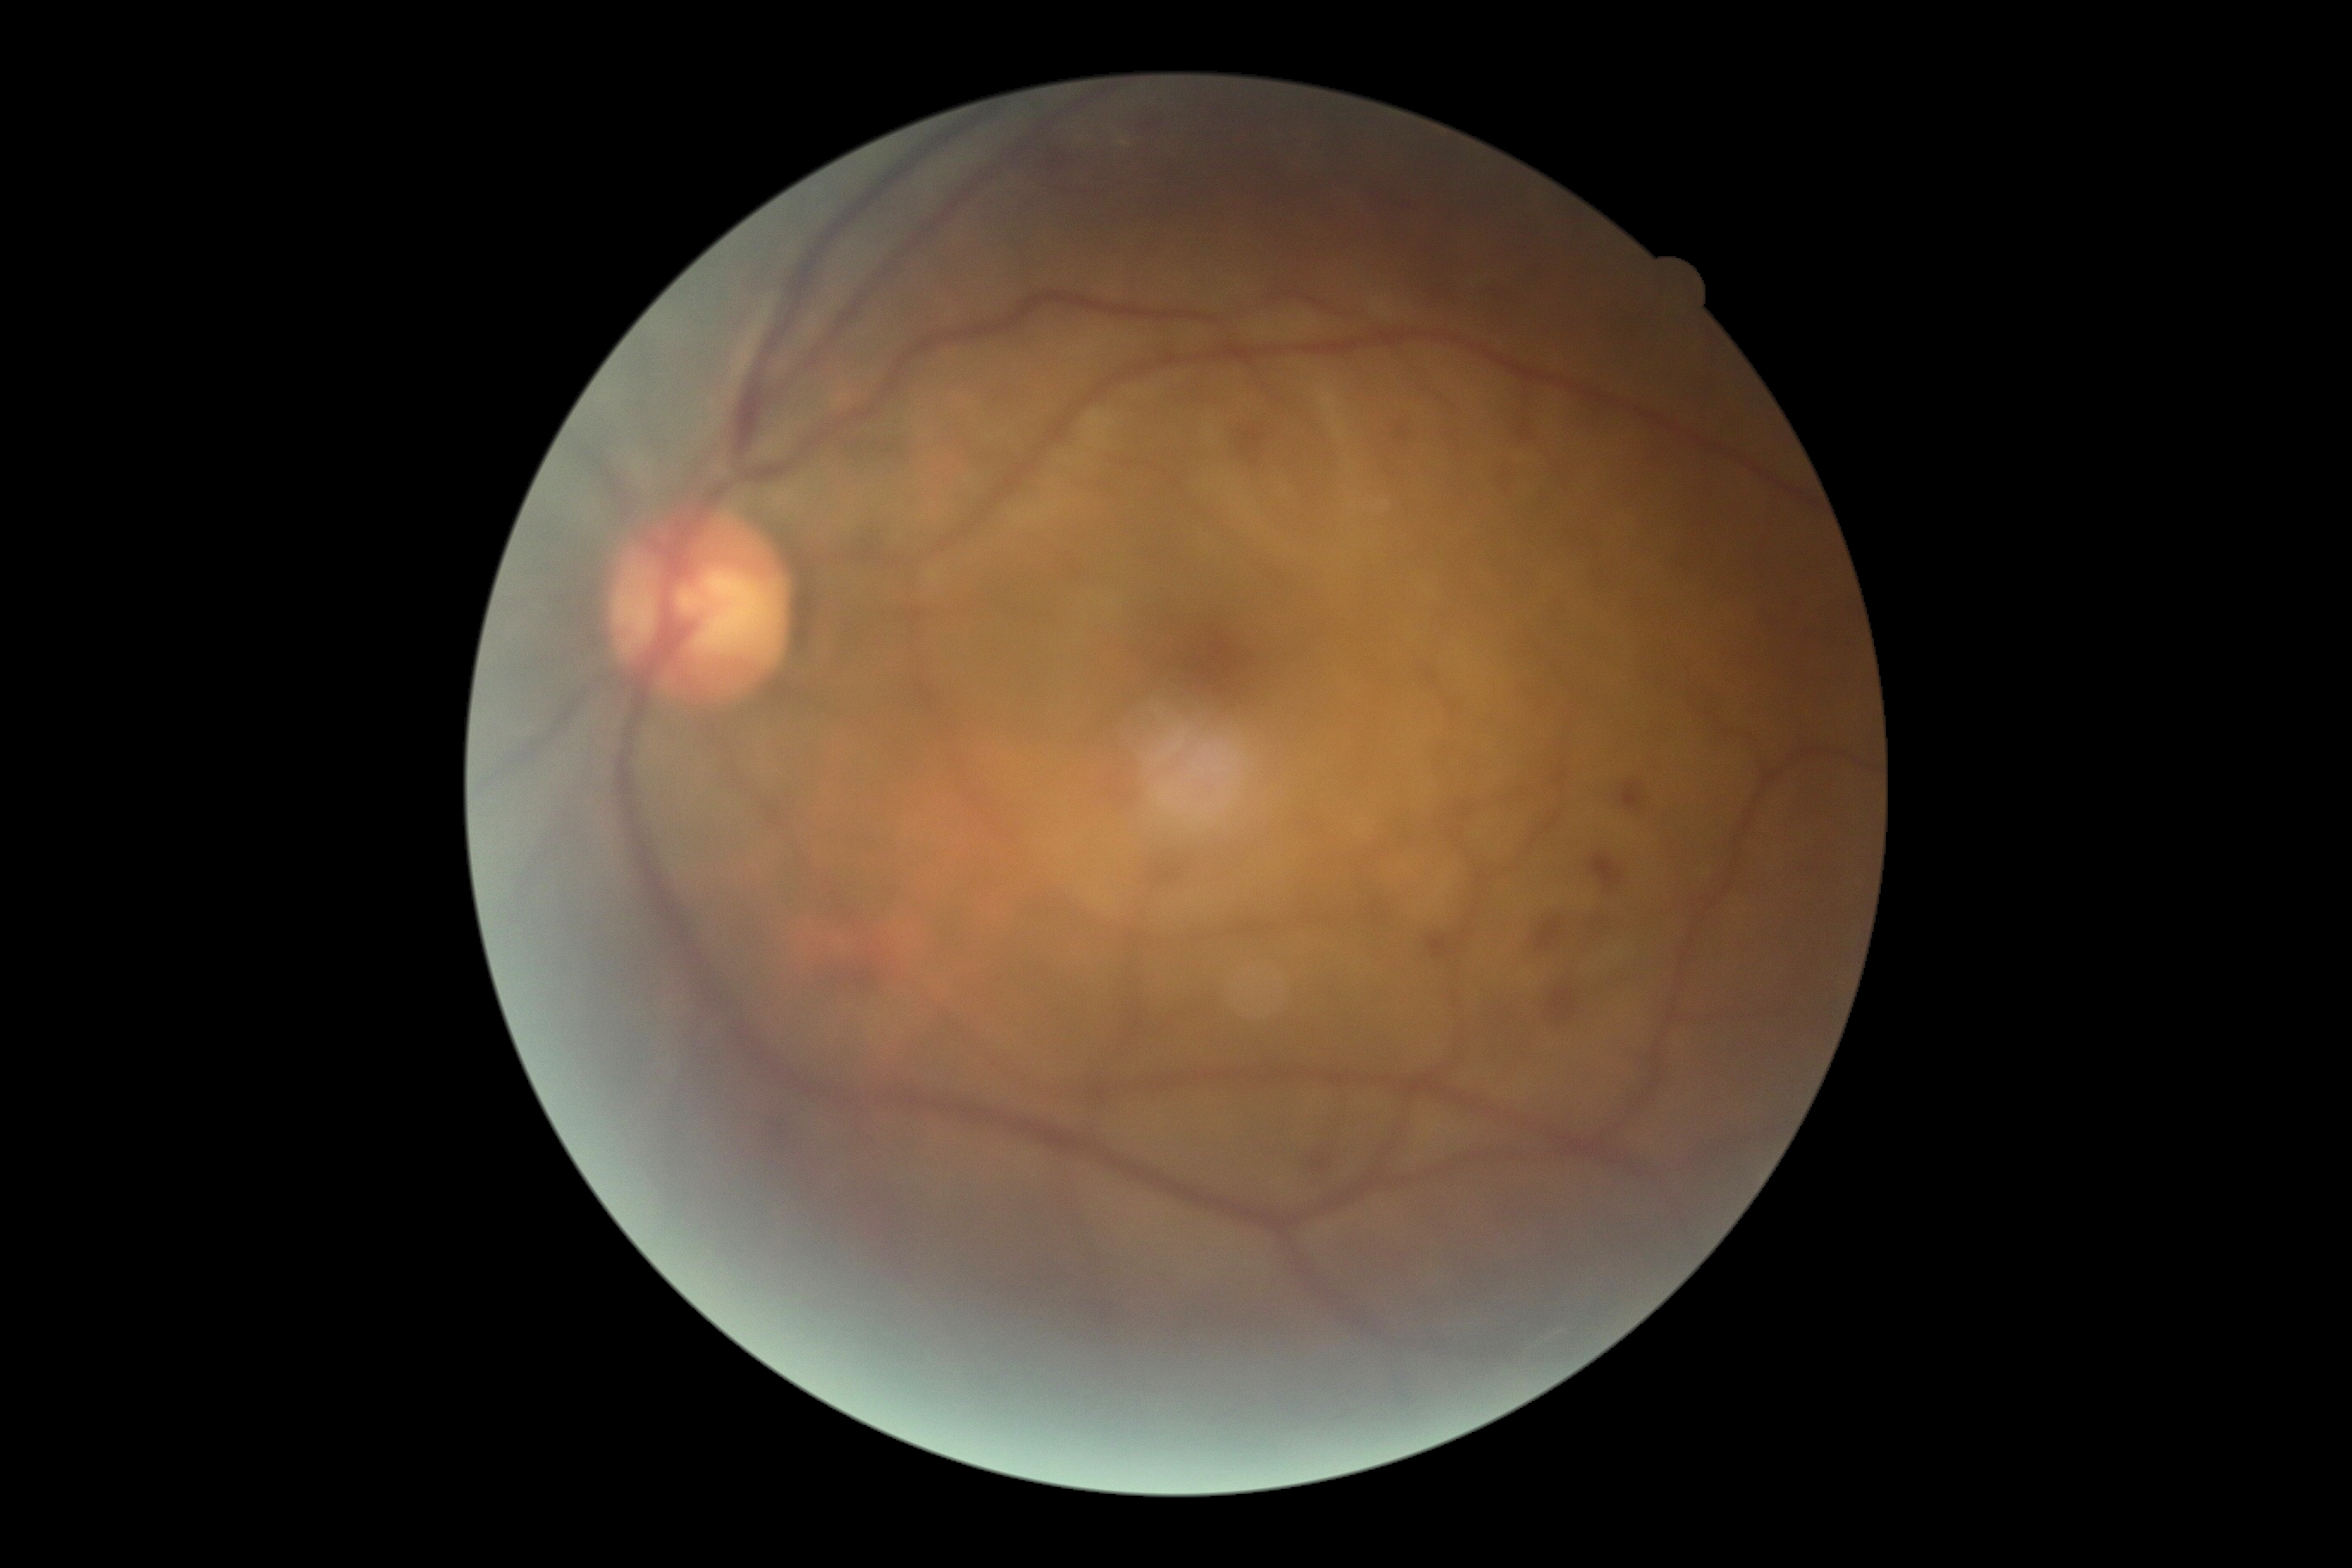

Diabetic retinopathy grade: moderate non-proliferative diabetic retinopathy (2).